CFP. 2352x1568. 45° FOV.
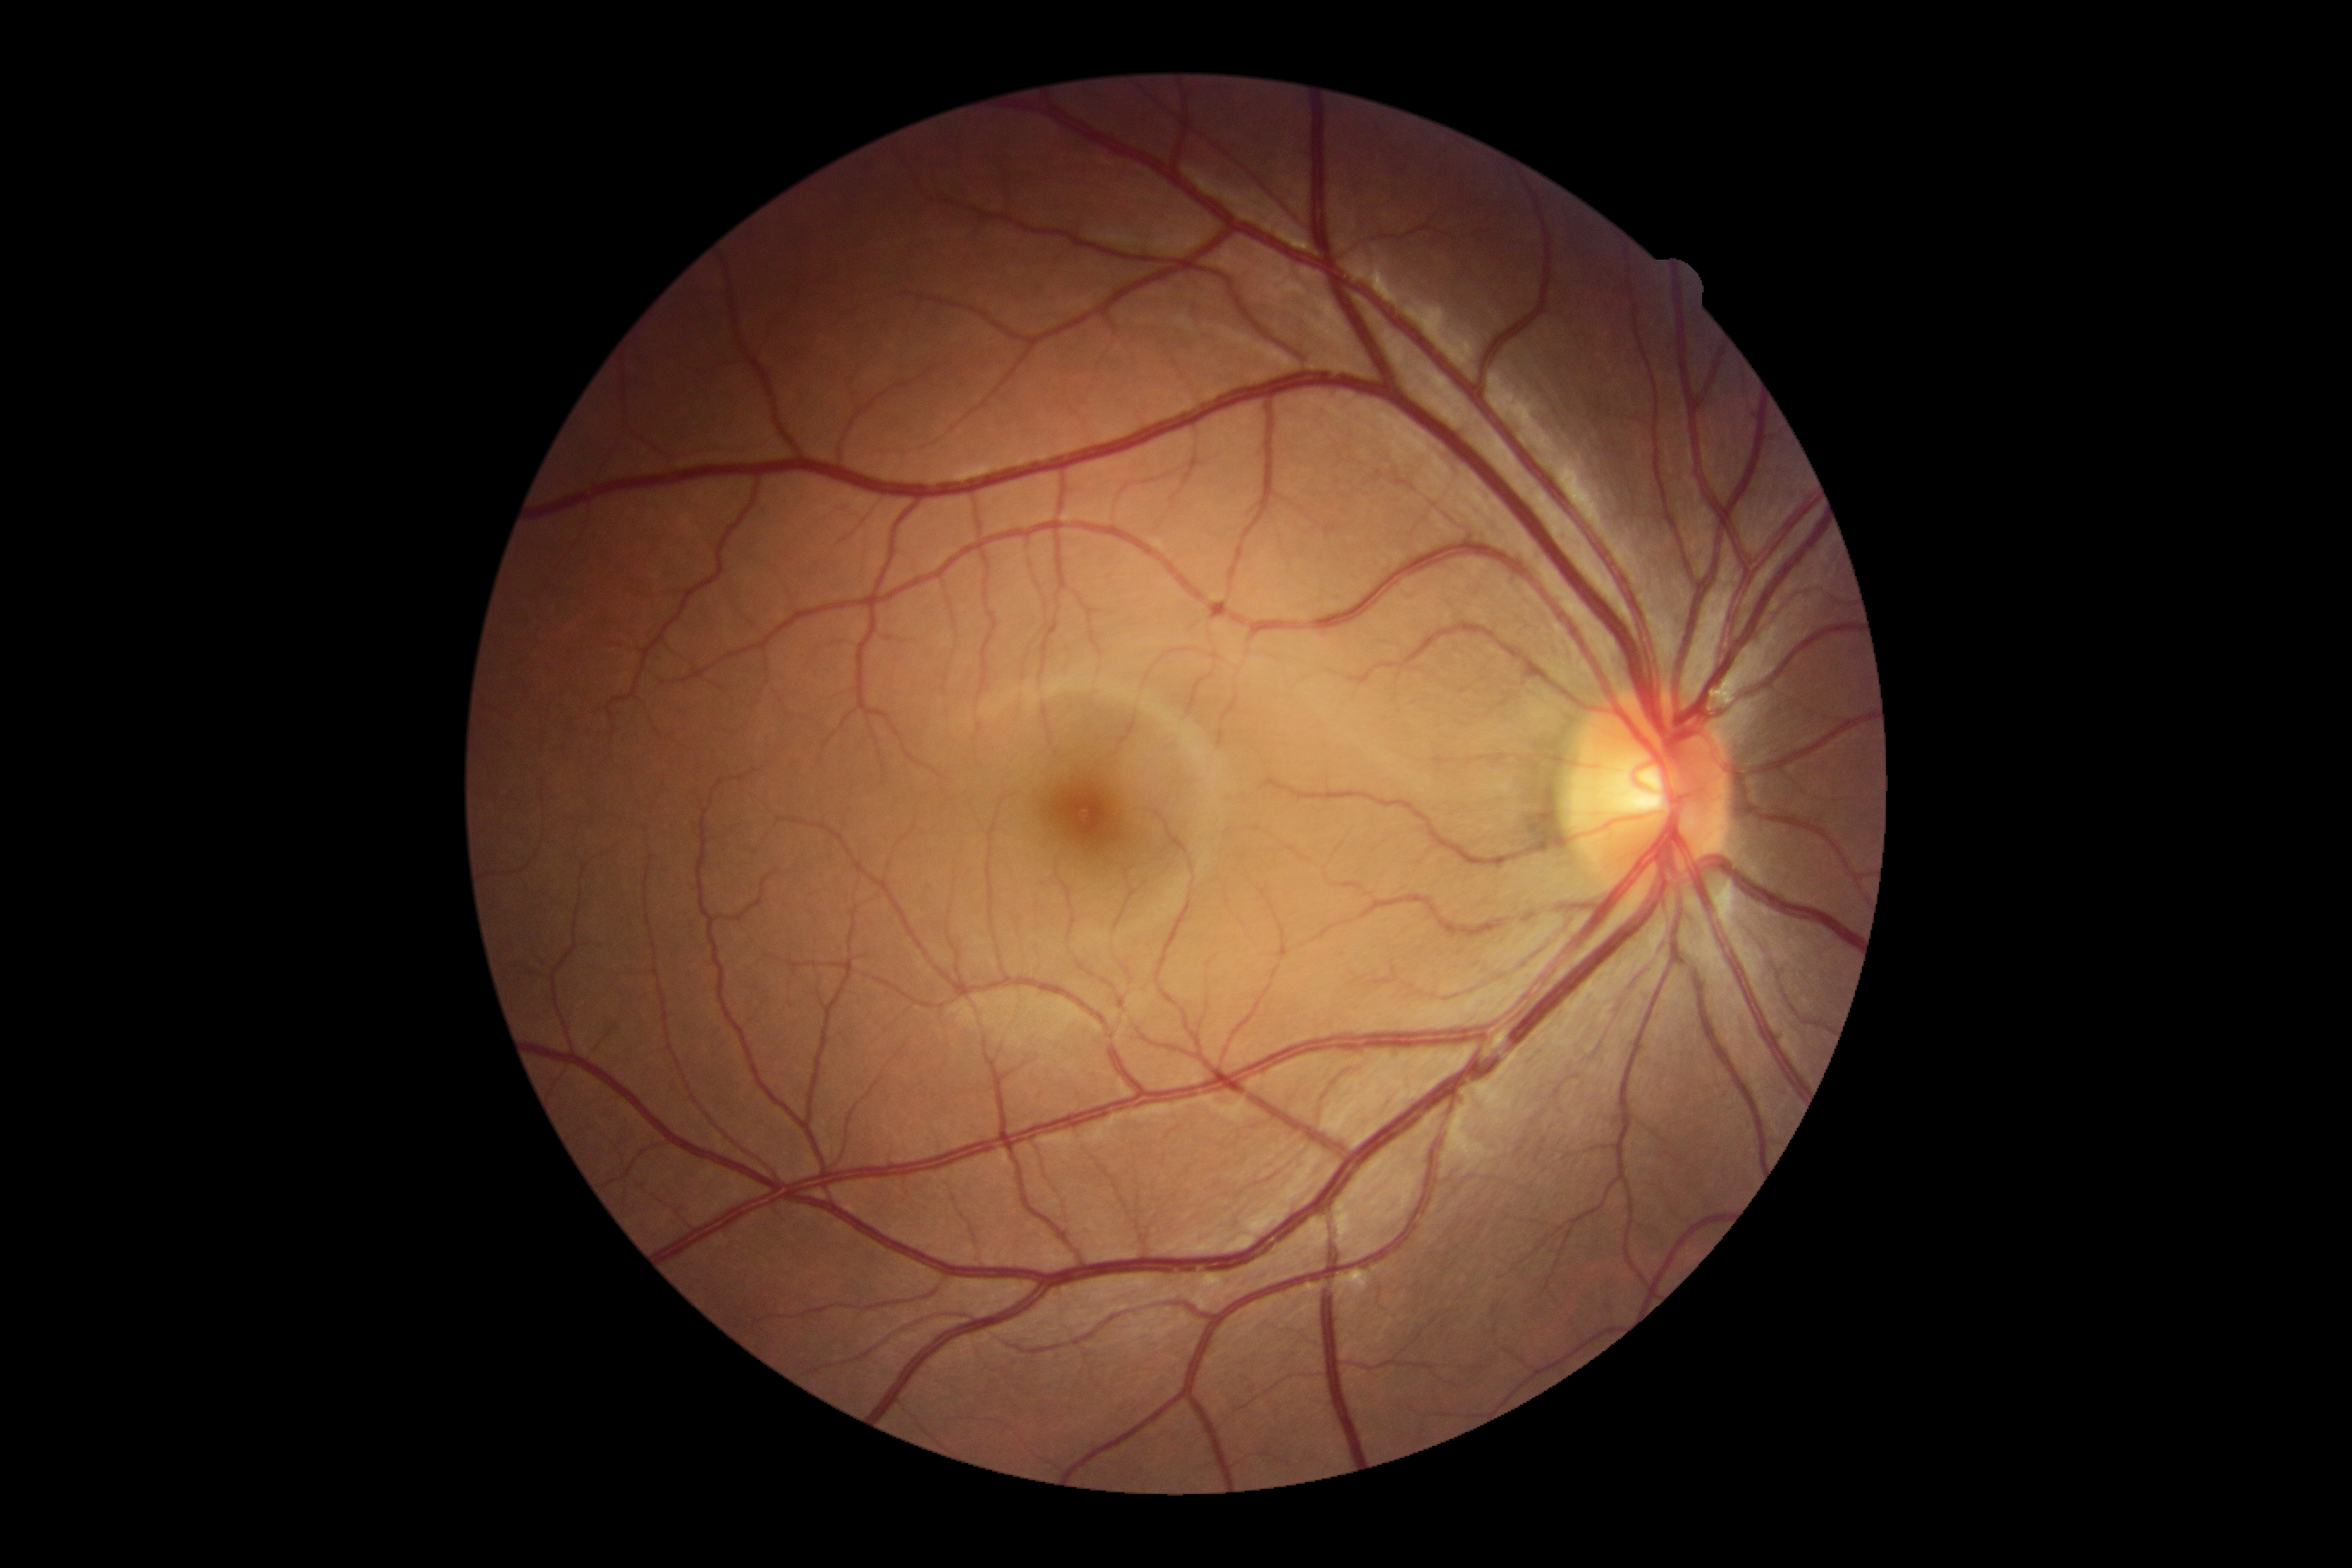

DR: grade 0 (no apparent retinopathy).